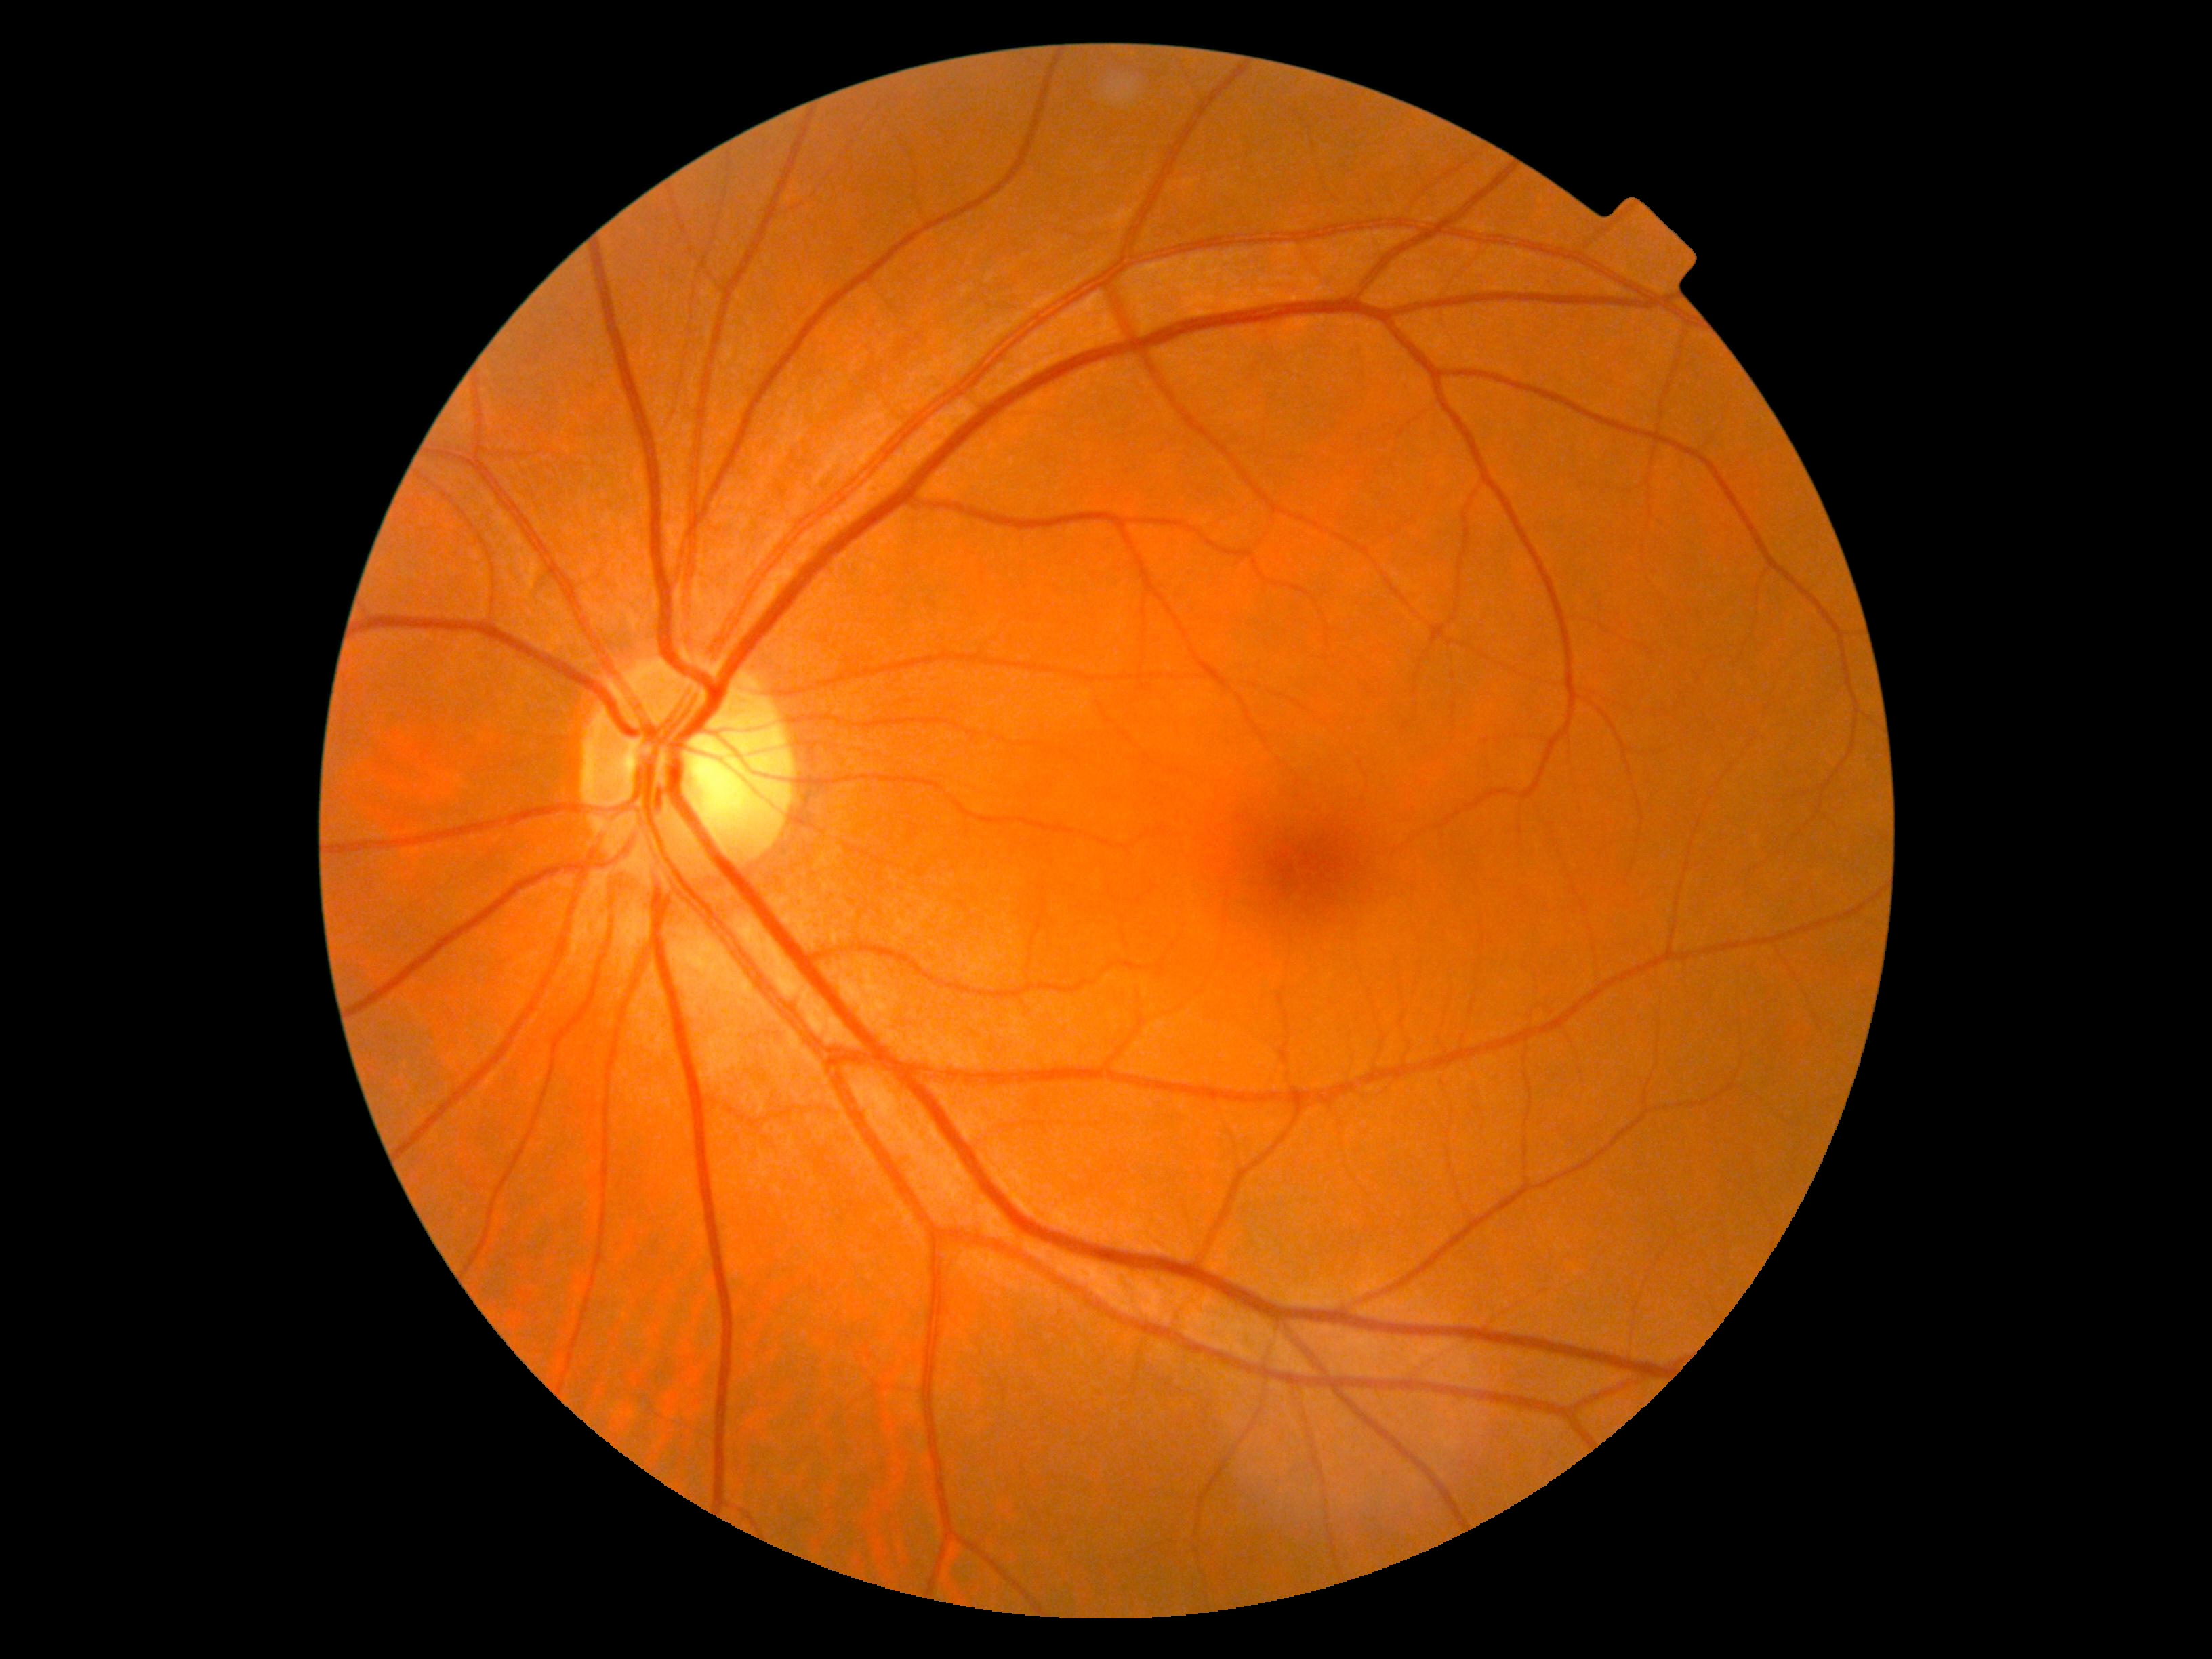

Diabetic retinopathy grade is no apparent diabetic retinopathy (0) — no visible signs of diabetic retinopathy.